Nonmydriatic. 848x848
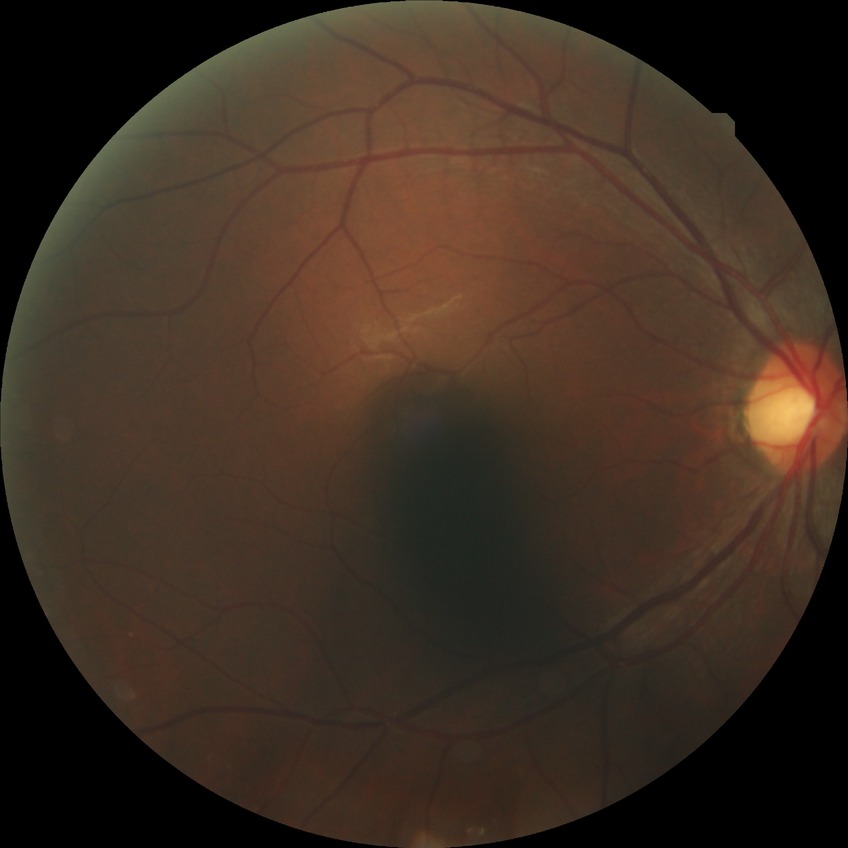

{"davis_grade": "no diabetic retinopathy (NDR)"}